45° field of view — 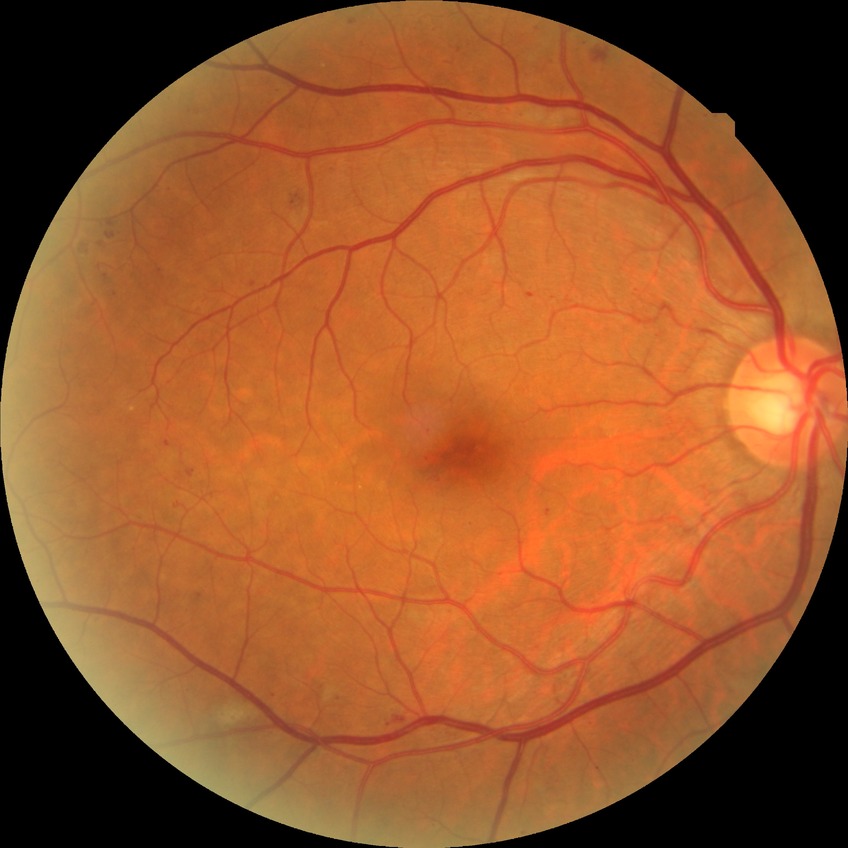

Retinopathy grade: pre-proliferative diabetic retinopathy.